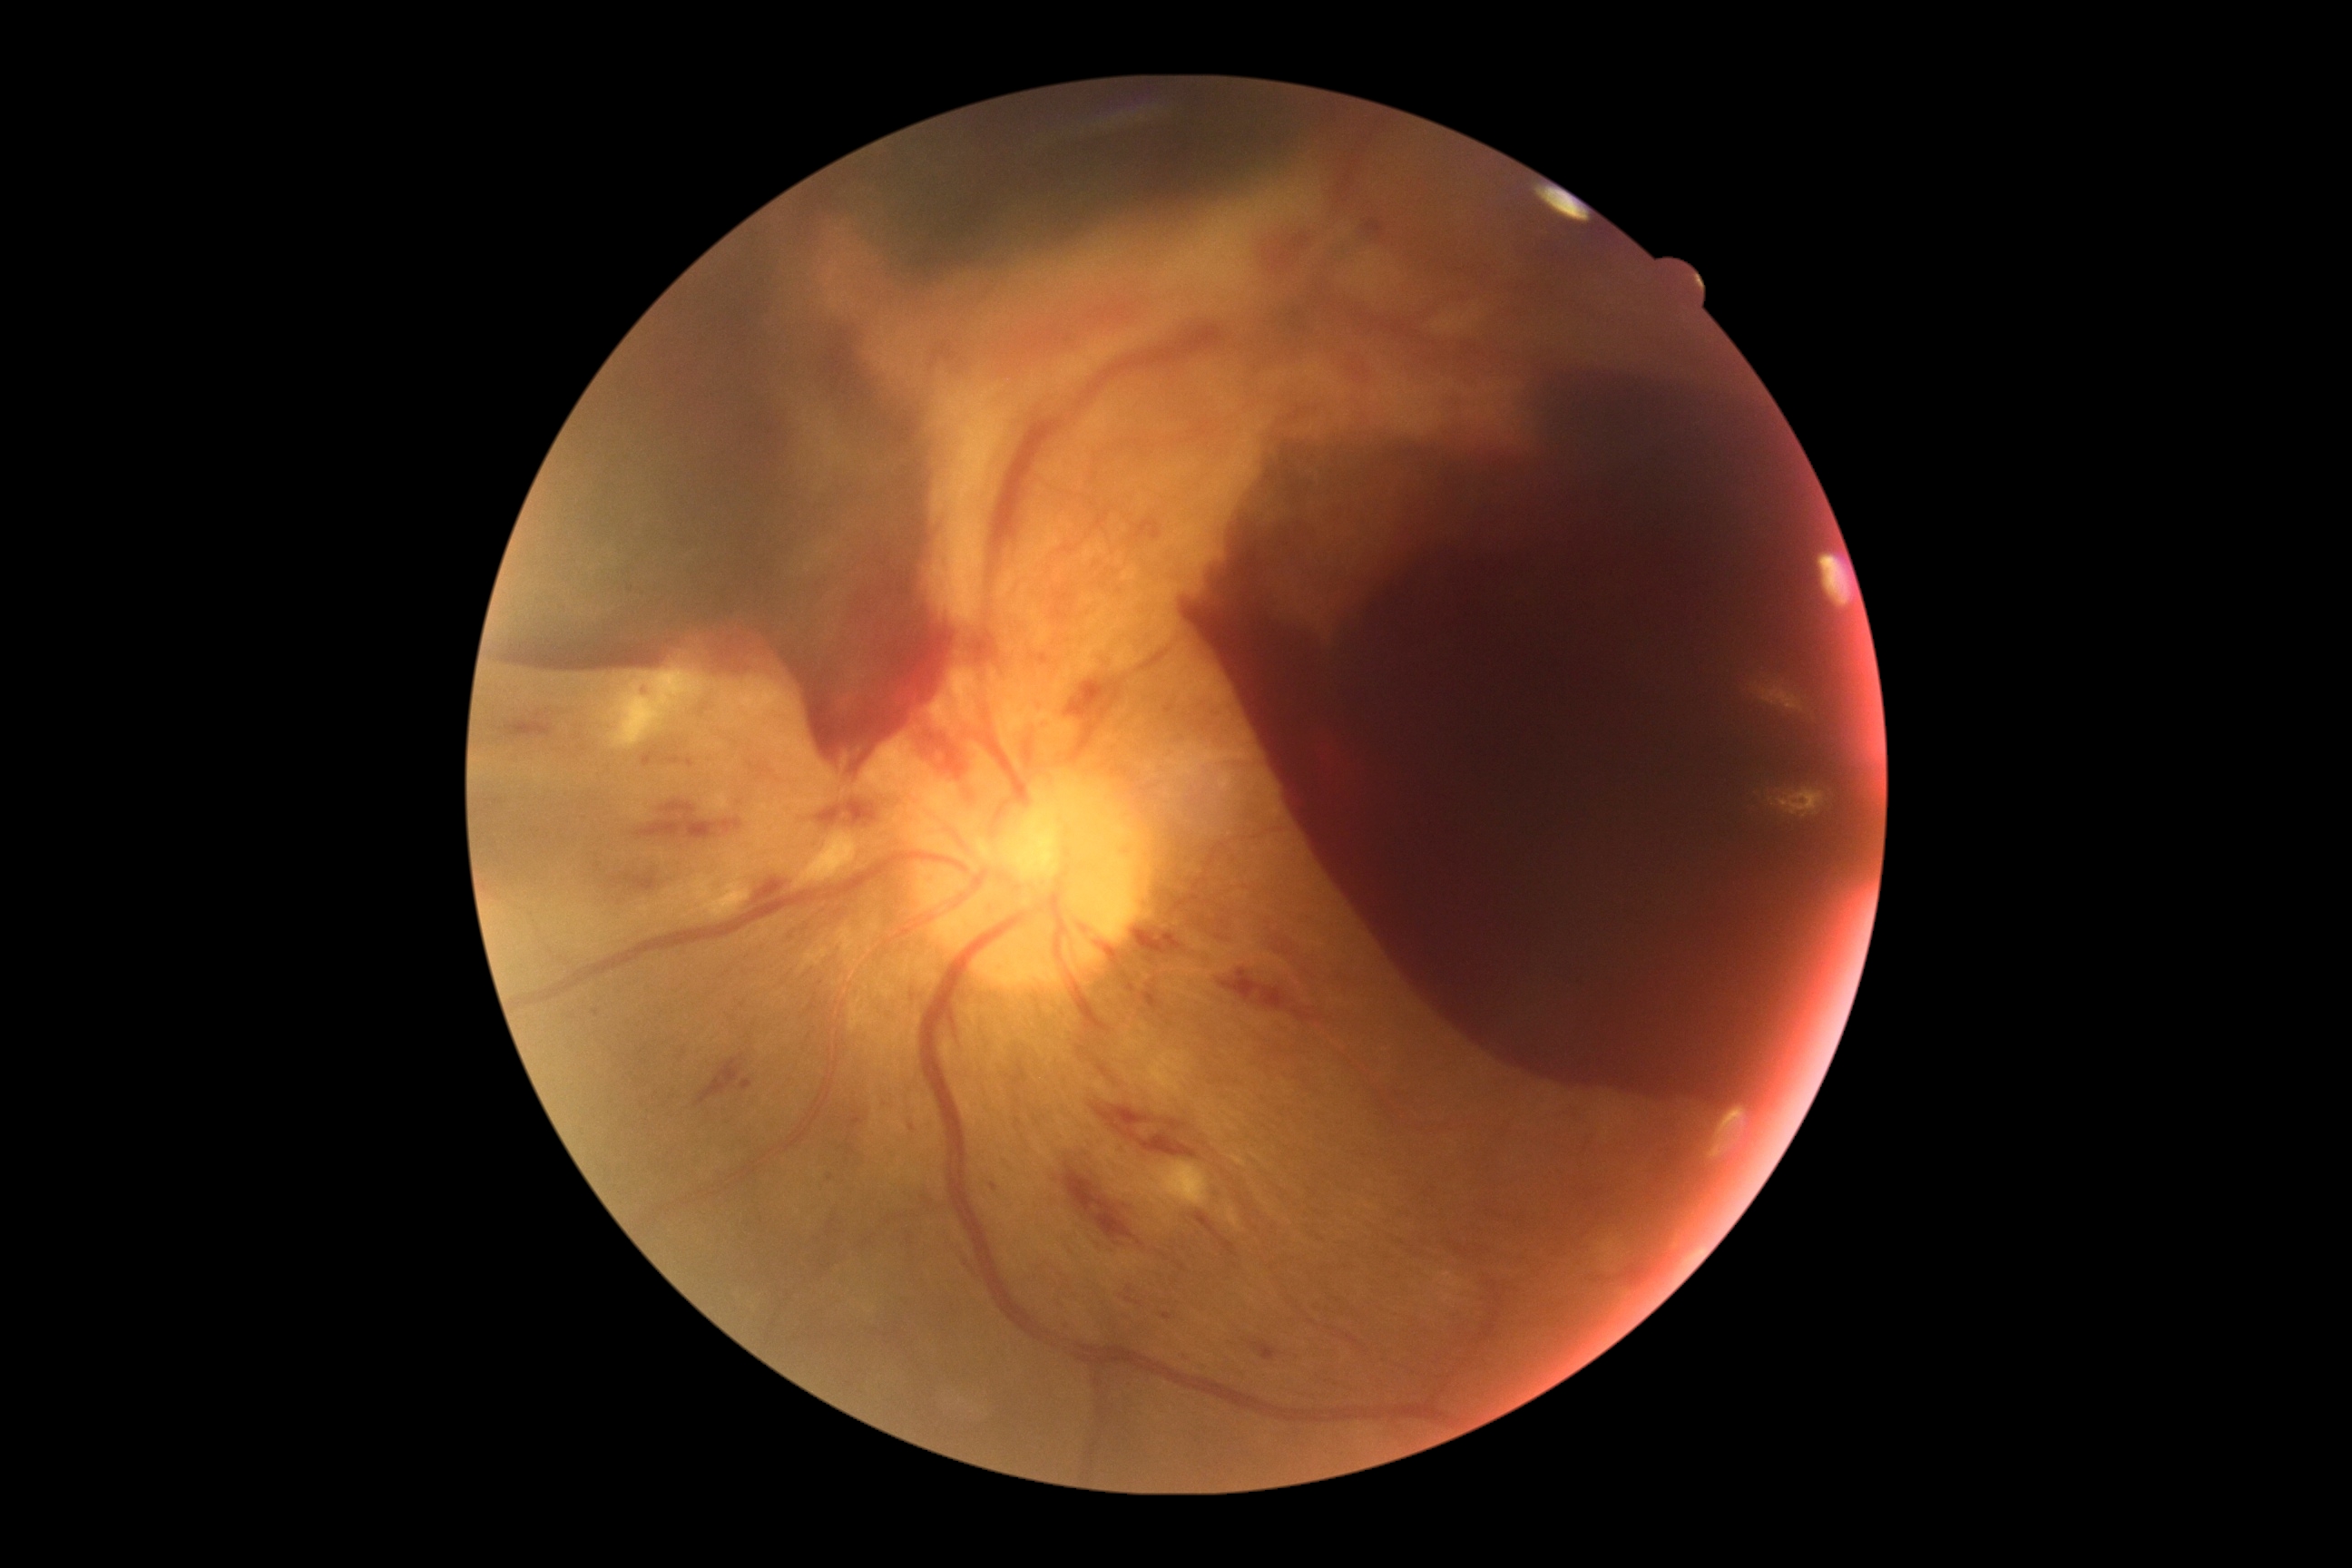 * retinopathy: PDR (grade 4)
* DR class: proliferative diabetic retinopathy